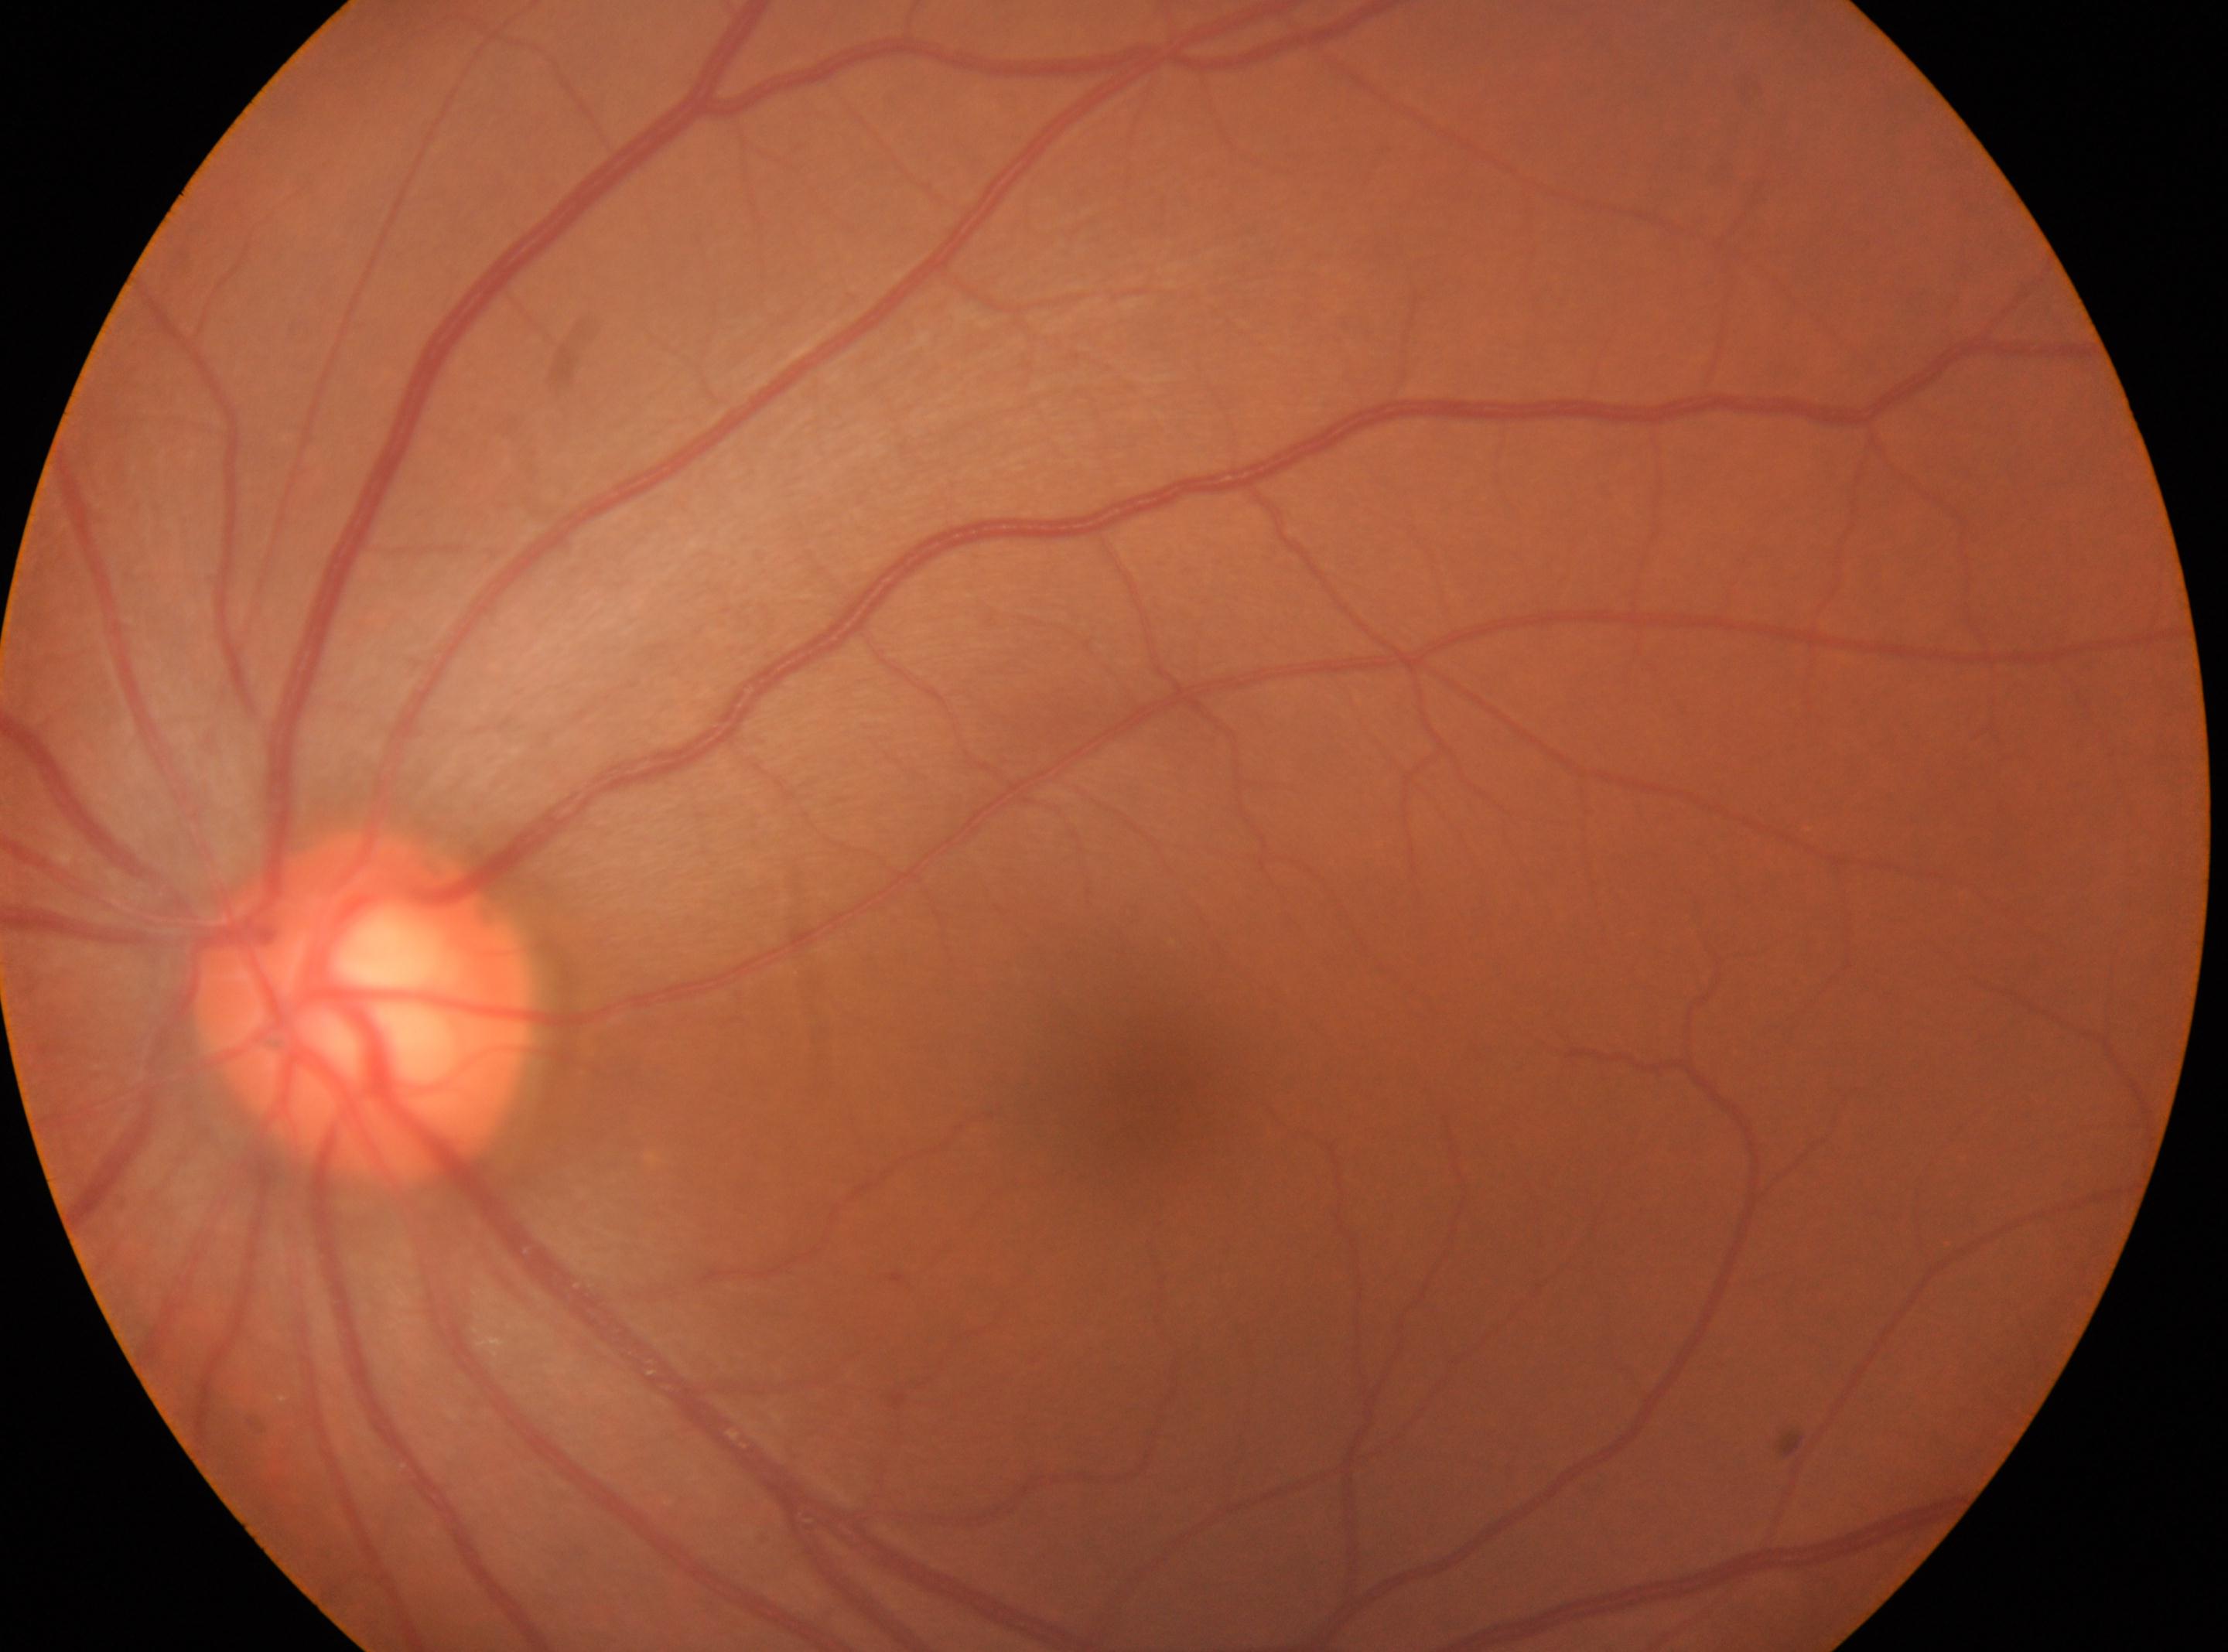 Annotations:
* diabetic retinopathy (DR) · no apparent diabetic retinopathy (grade 0)
* optic nerve head · 359, 1010
* fovea centralis · 1151, 1087
* eye · OS
* DR impression · No diabetic retinopathy identified